Infant wide-field fundus photograph · captured with the Clarity RetCam 3 (130° field of view).
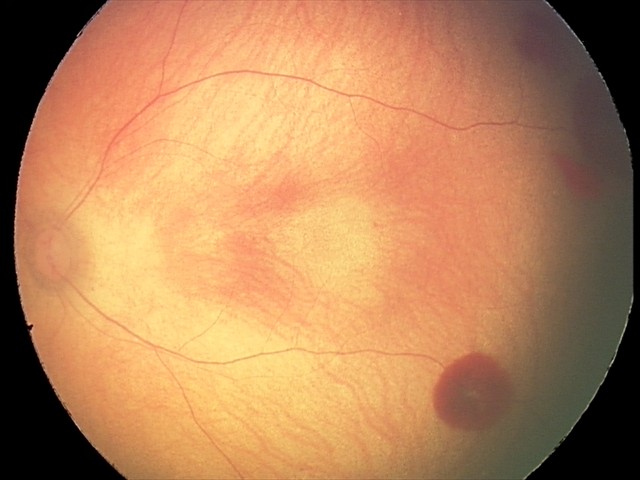 Screening examination consistent with retinal hemorrhages.